Camera: Topcon TRC-50DX.
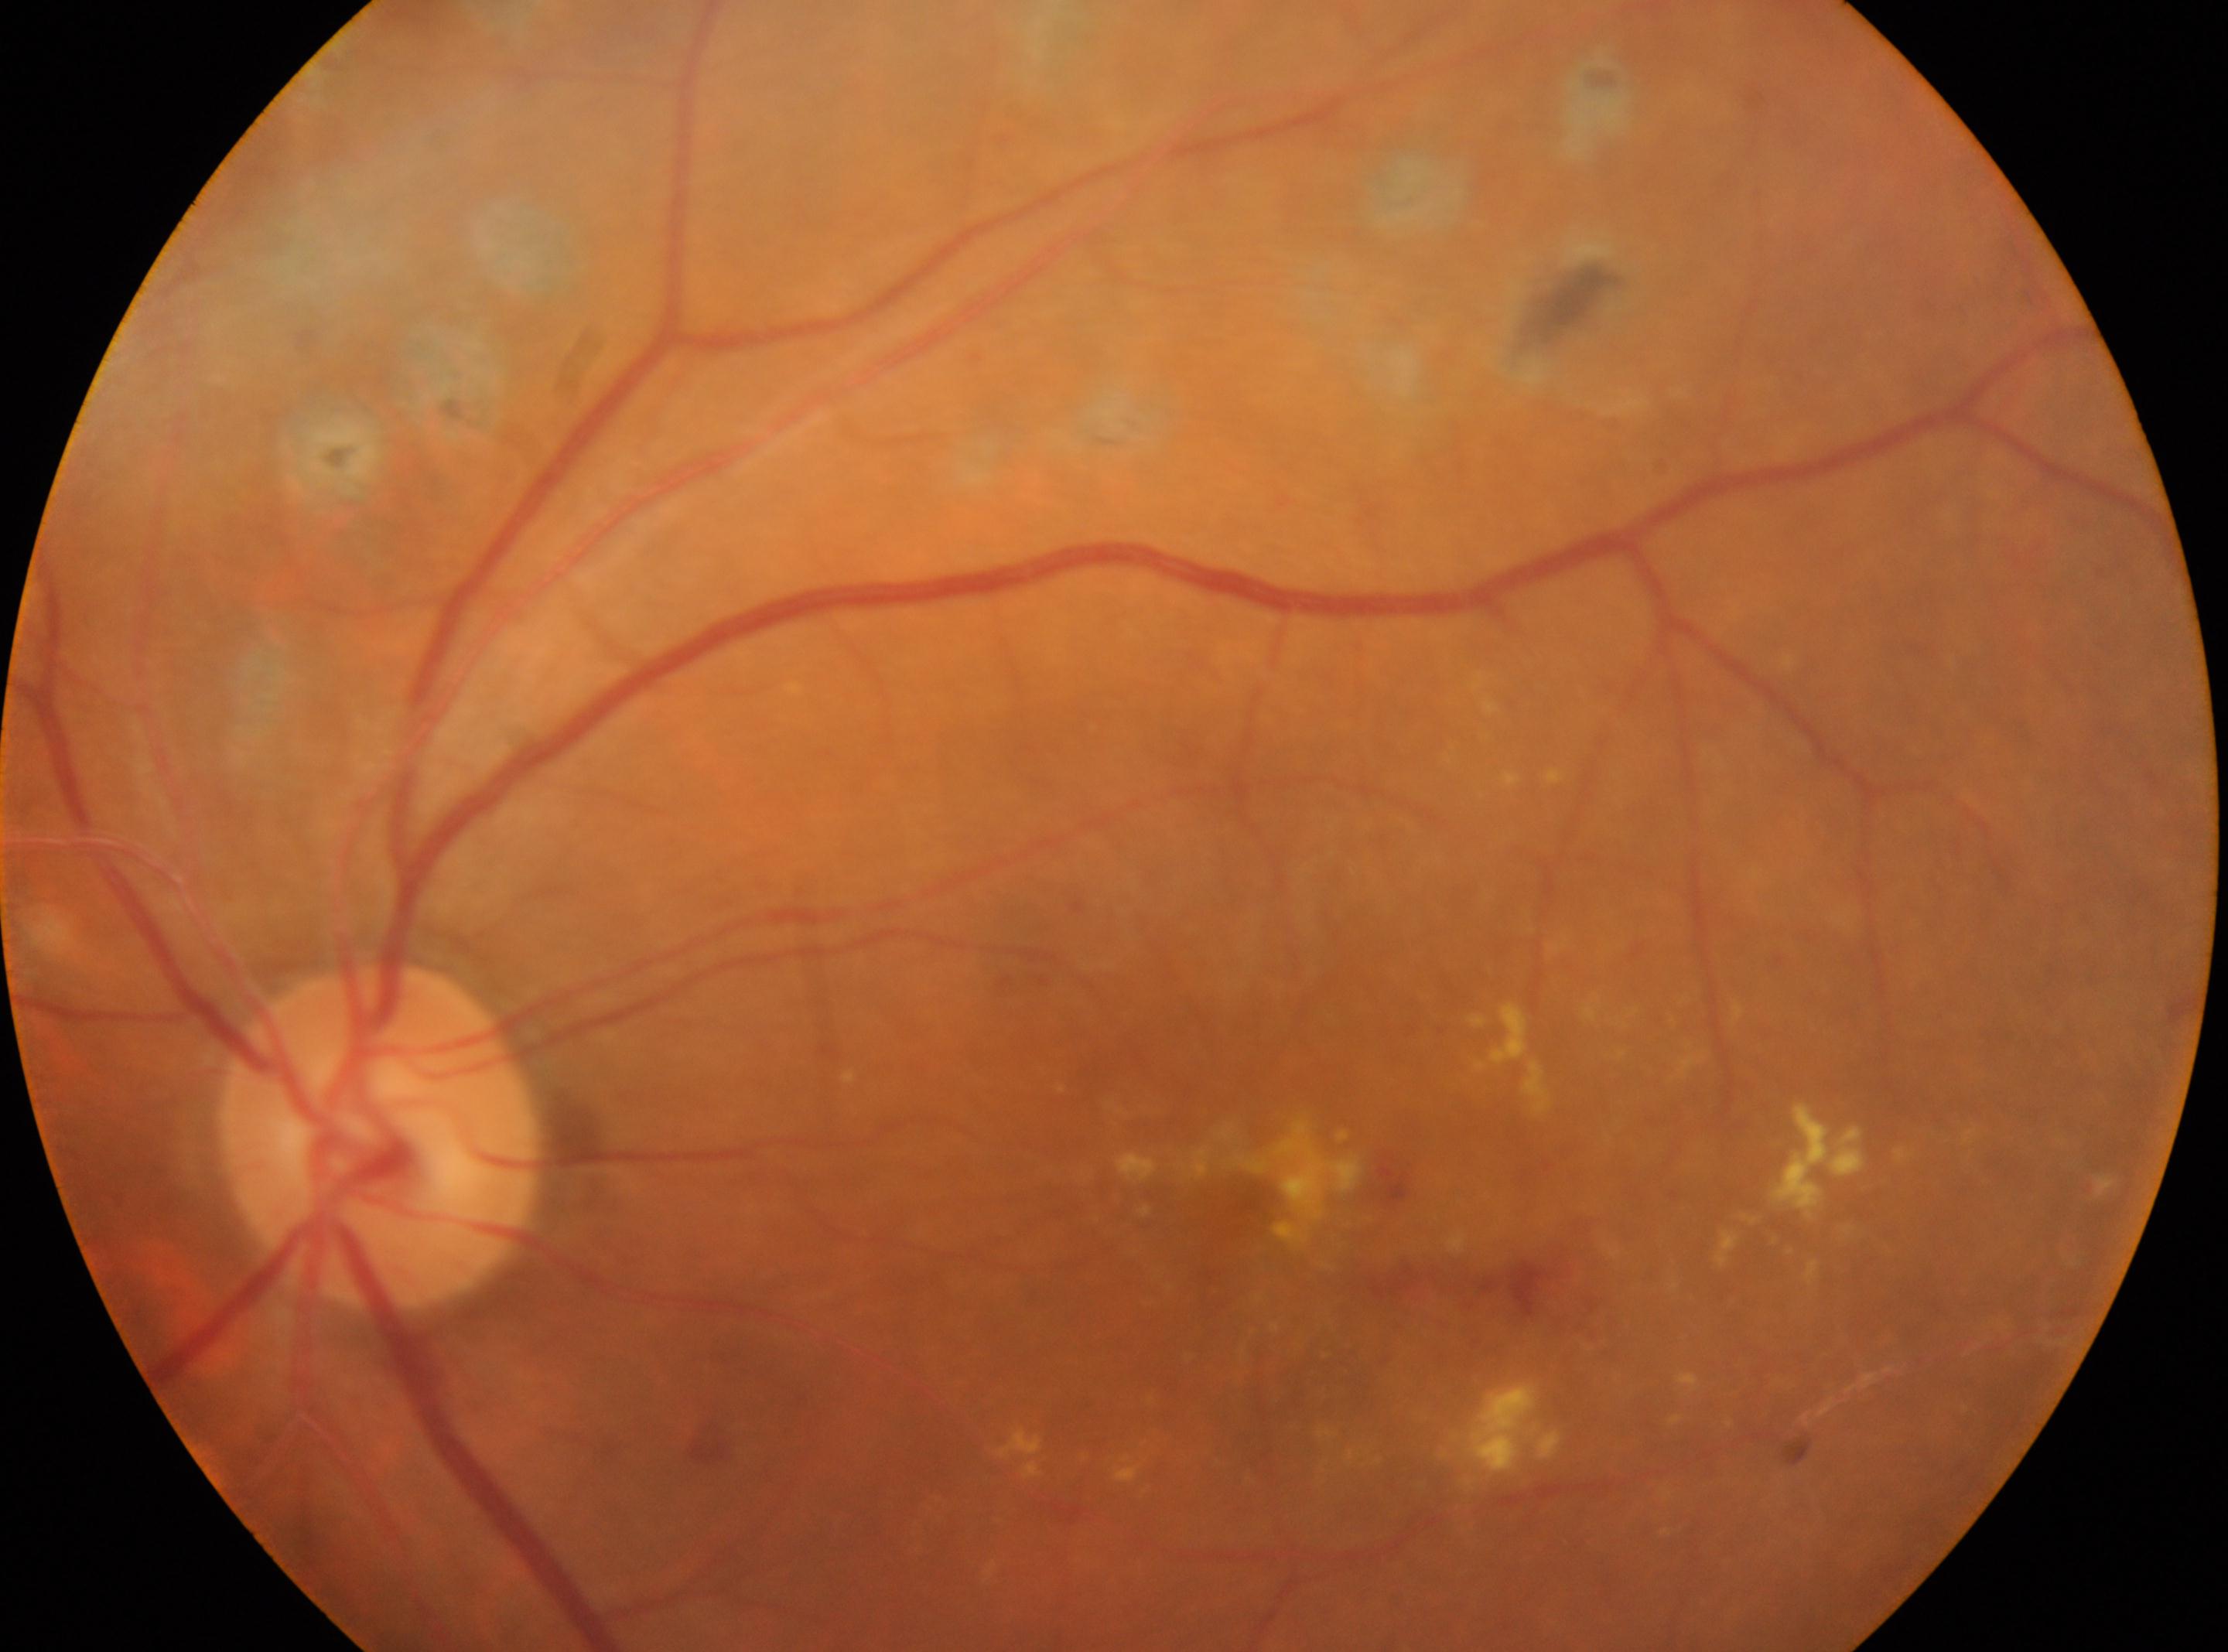
Q: Where is the optic disc?
A: (379, 1137)
Q: Fovea center?
A: (1269, 1239)
Q: Diabetic retinopathy severity?
A: DR with laser spots or scars, with underlying moderate NPDR (grade 2)
Q: Right or left eye?
A: the left eye